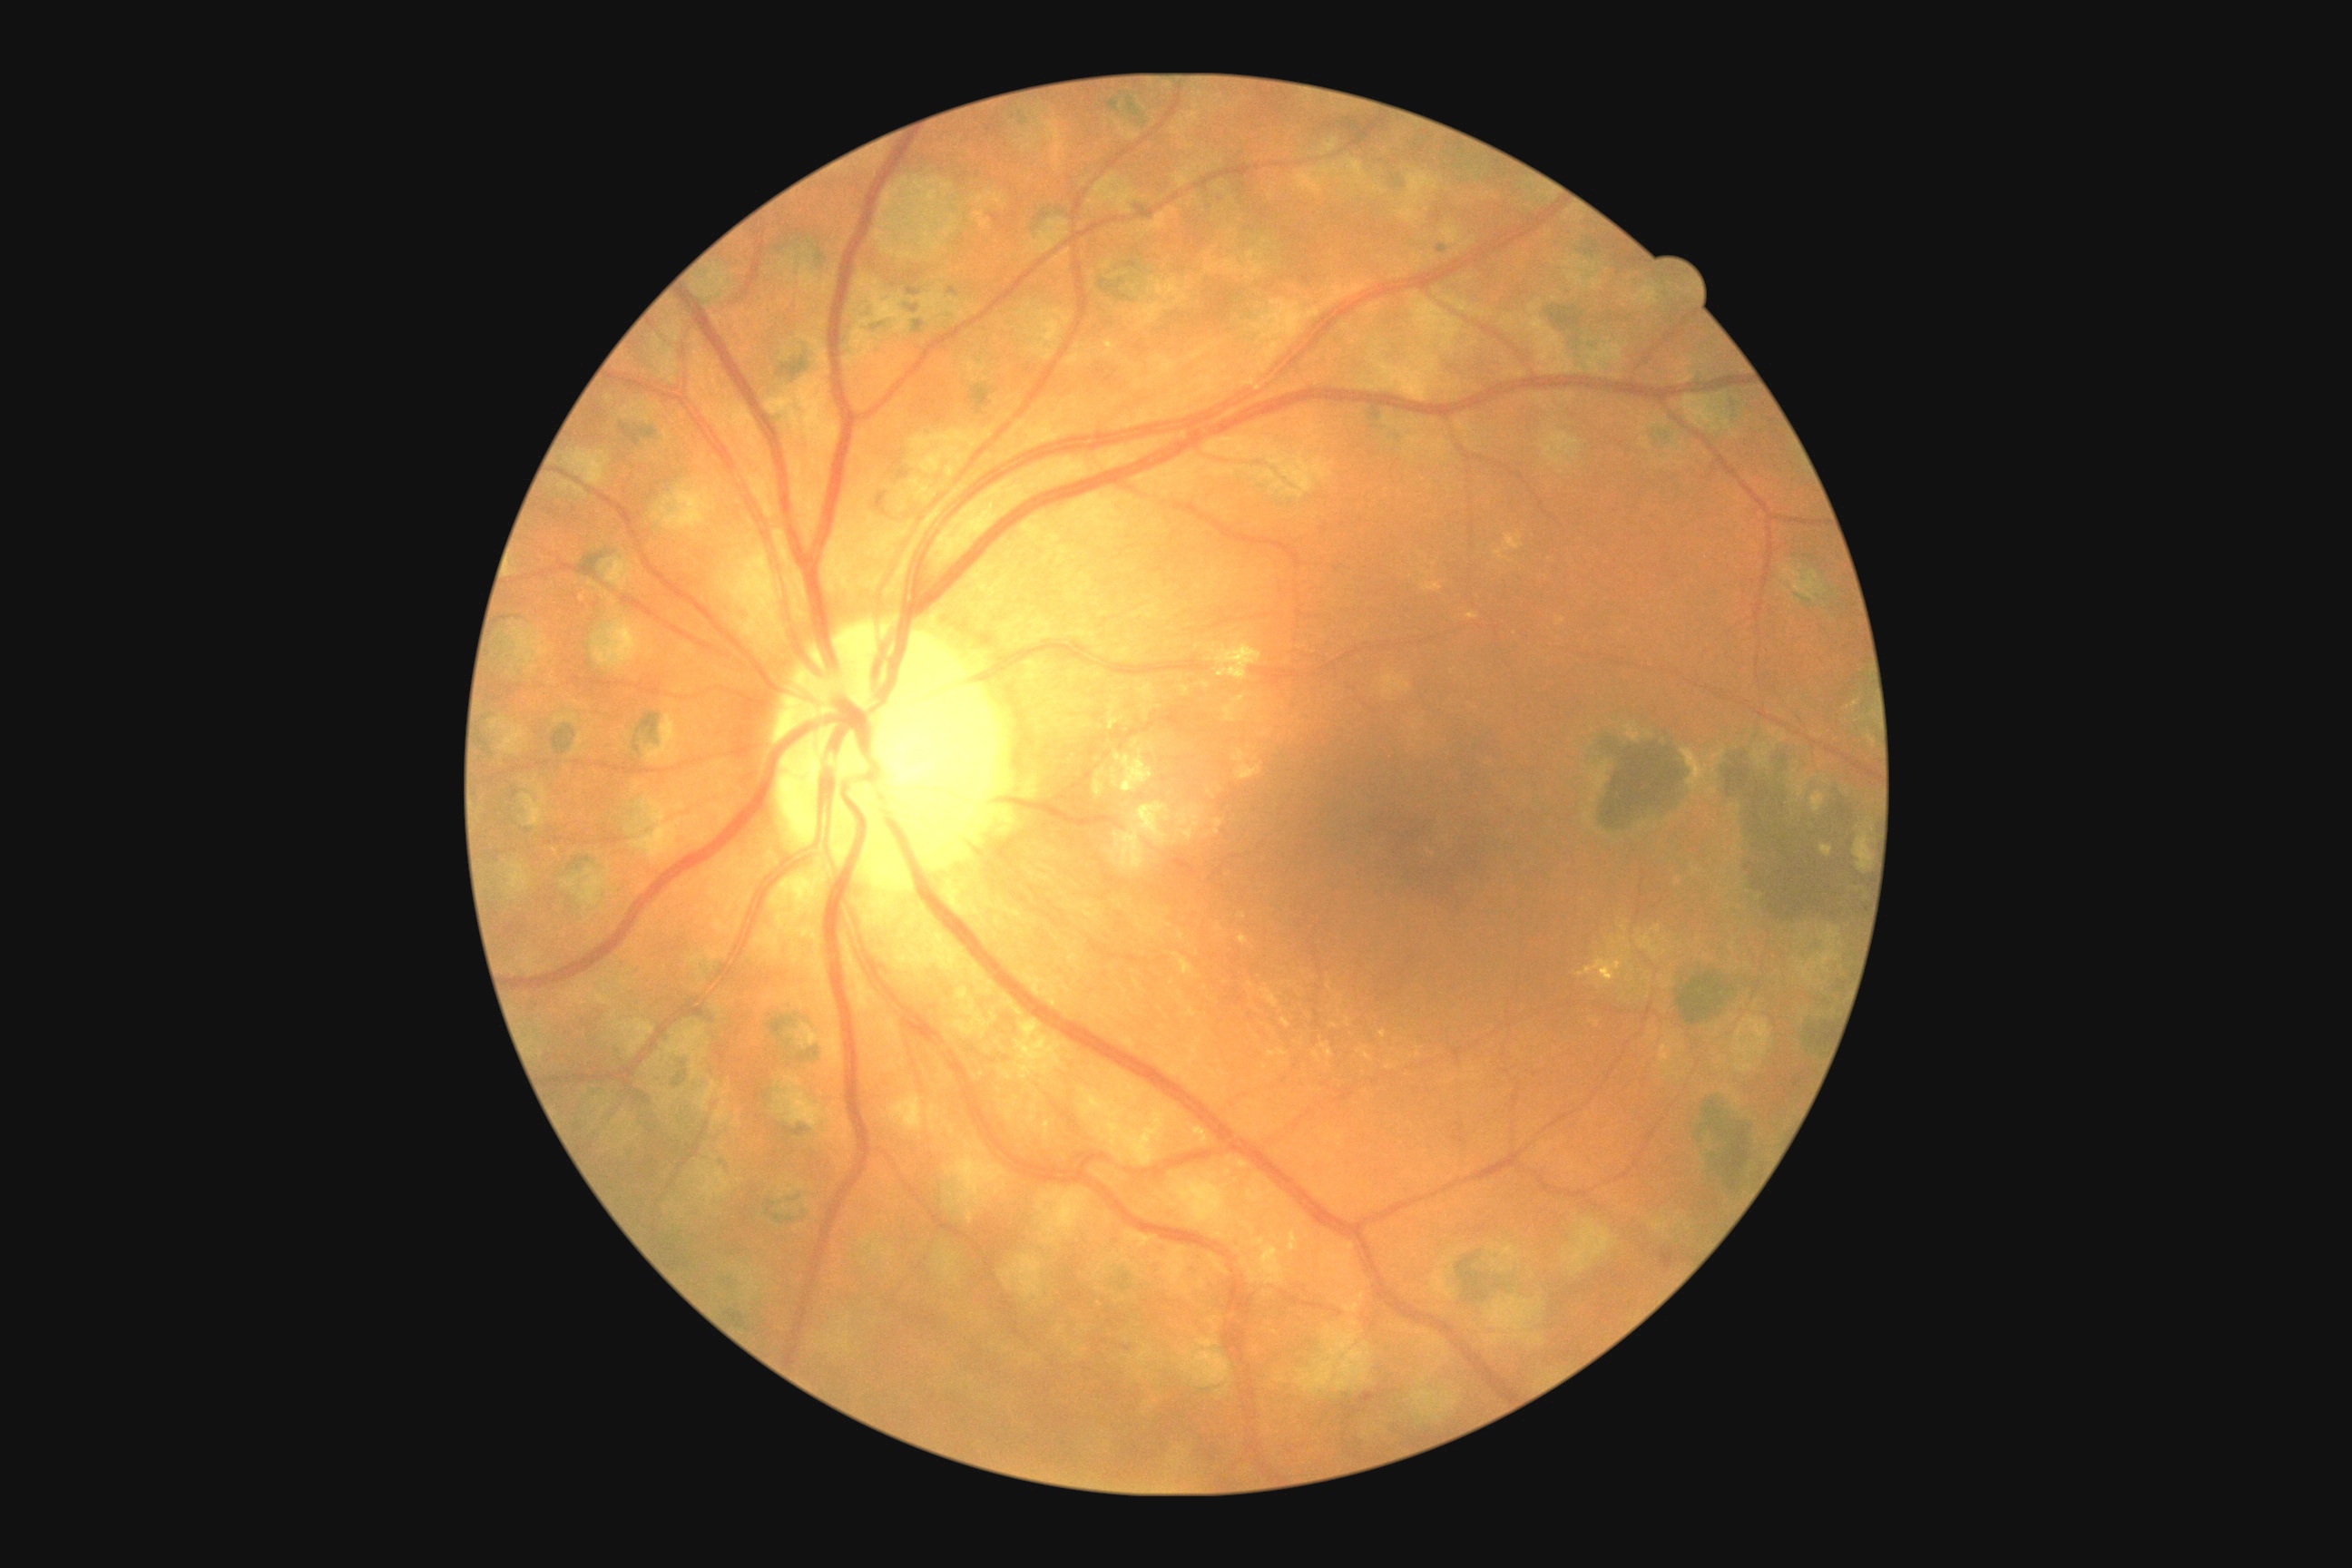 DR grade = moderate NPDR (2).